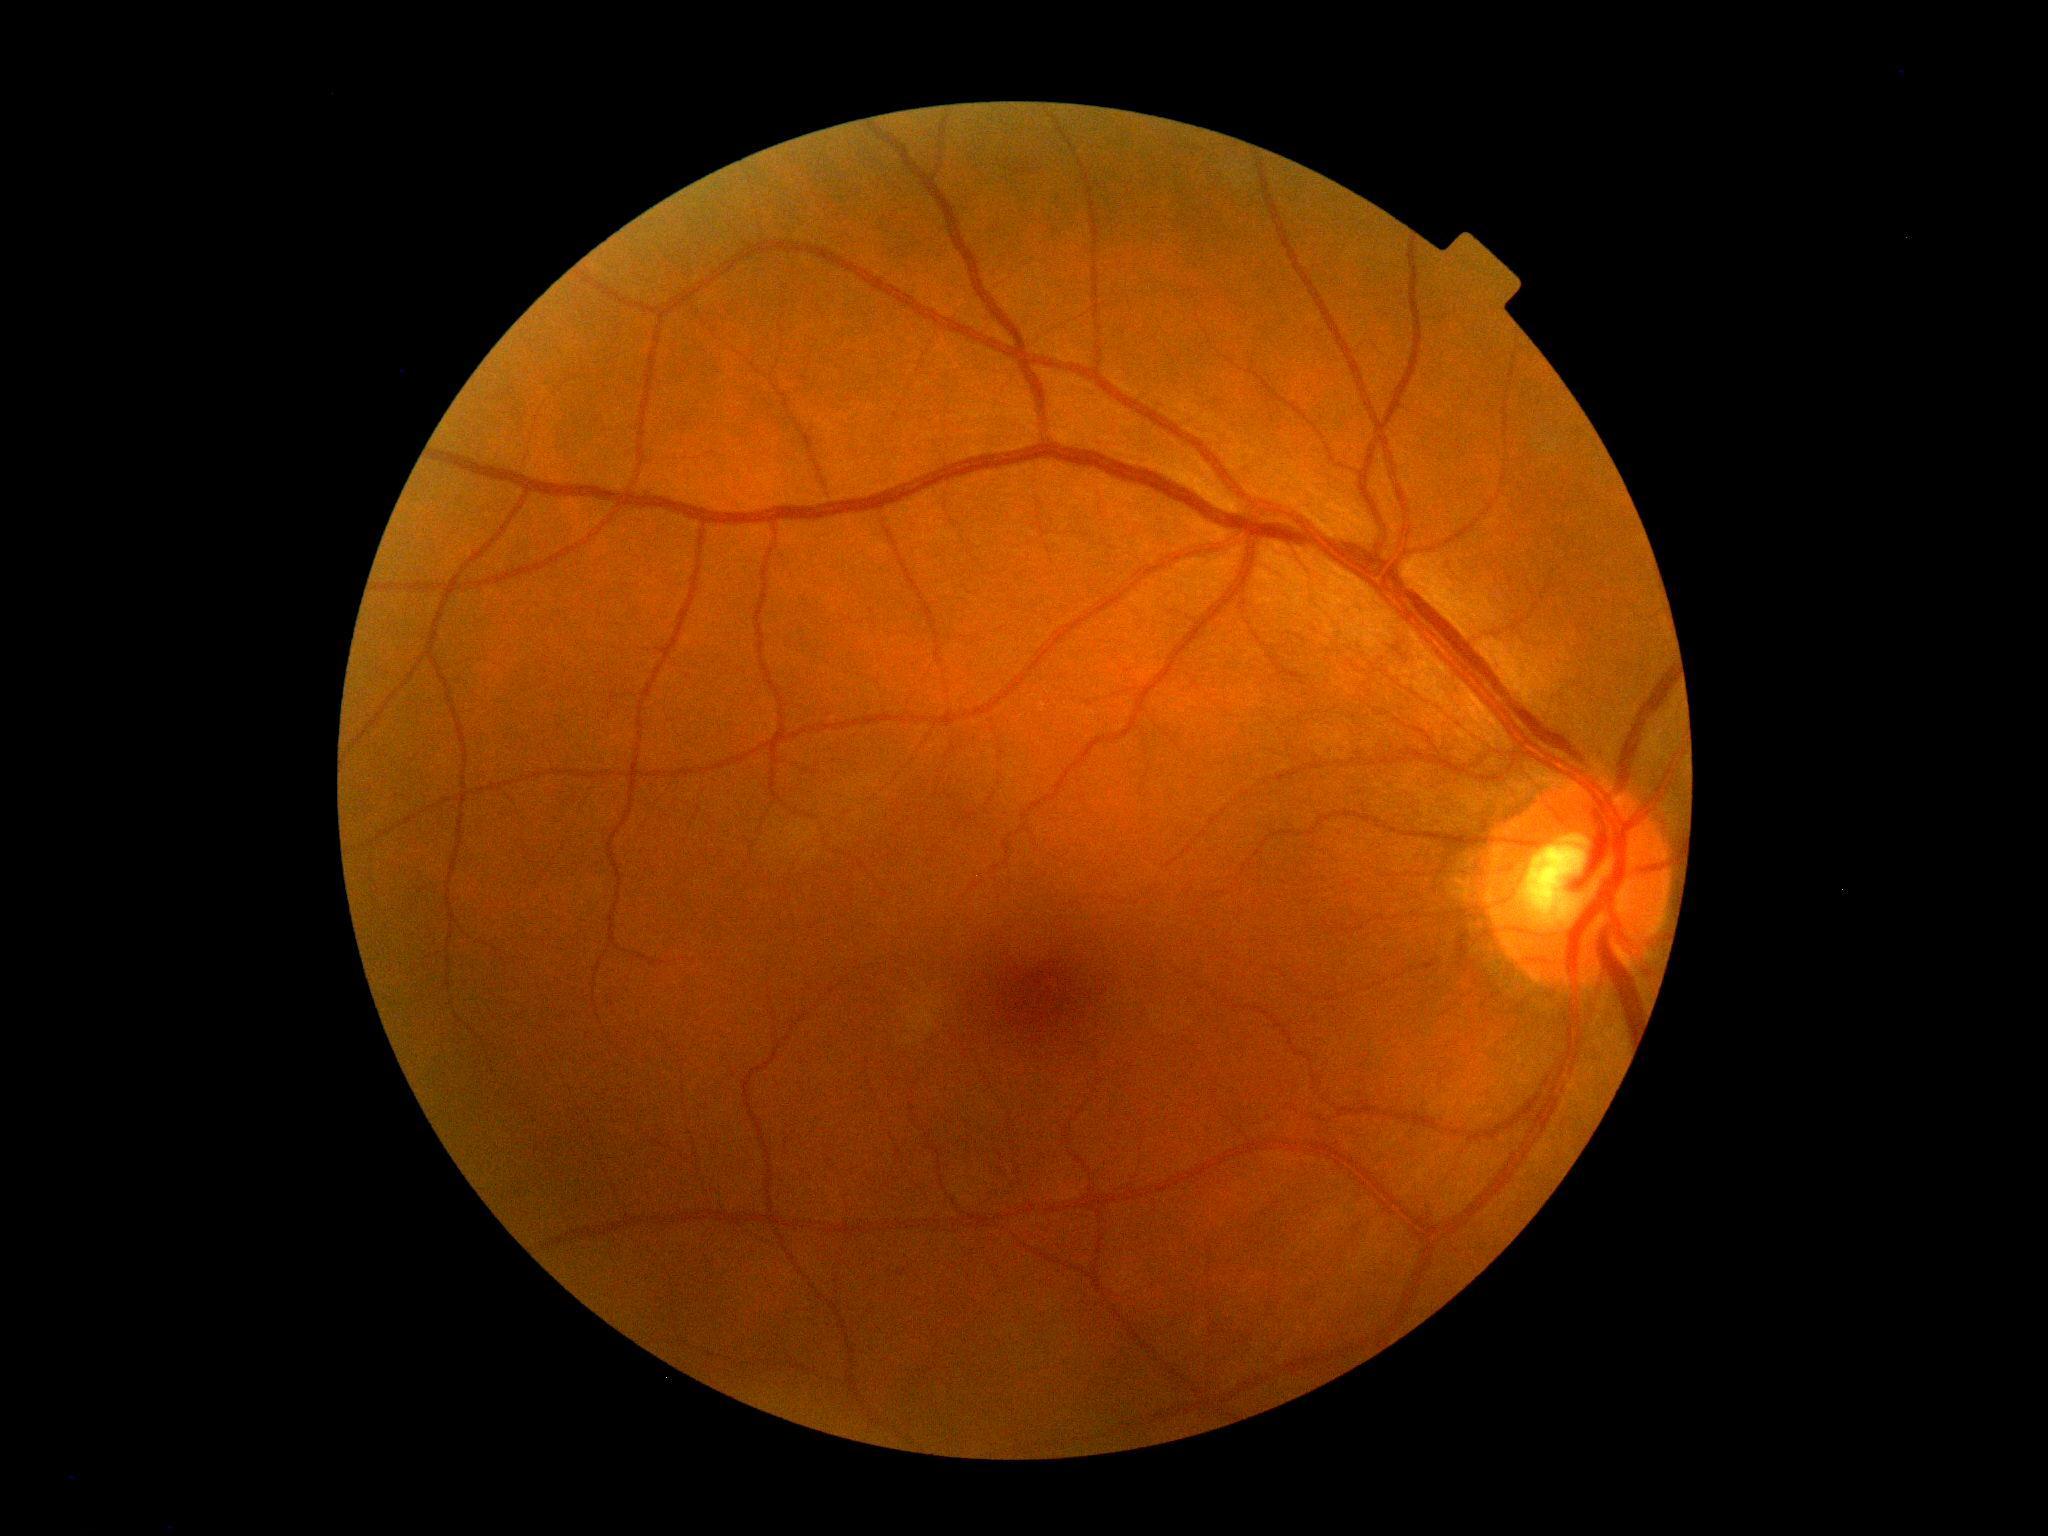

DR stage: grade 0 (no apparent retinopathy).
No apparent diabetic retinopathy.